CFP.
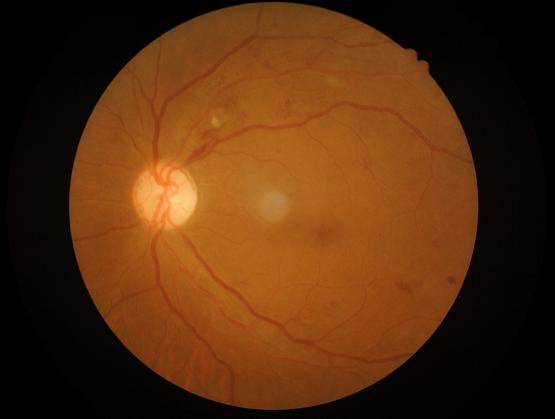
contrast: adequate
illumination: satisfactory
overall_quality: satisfactory